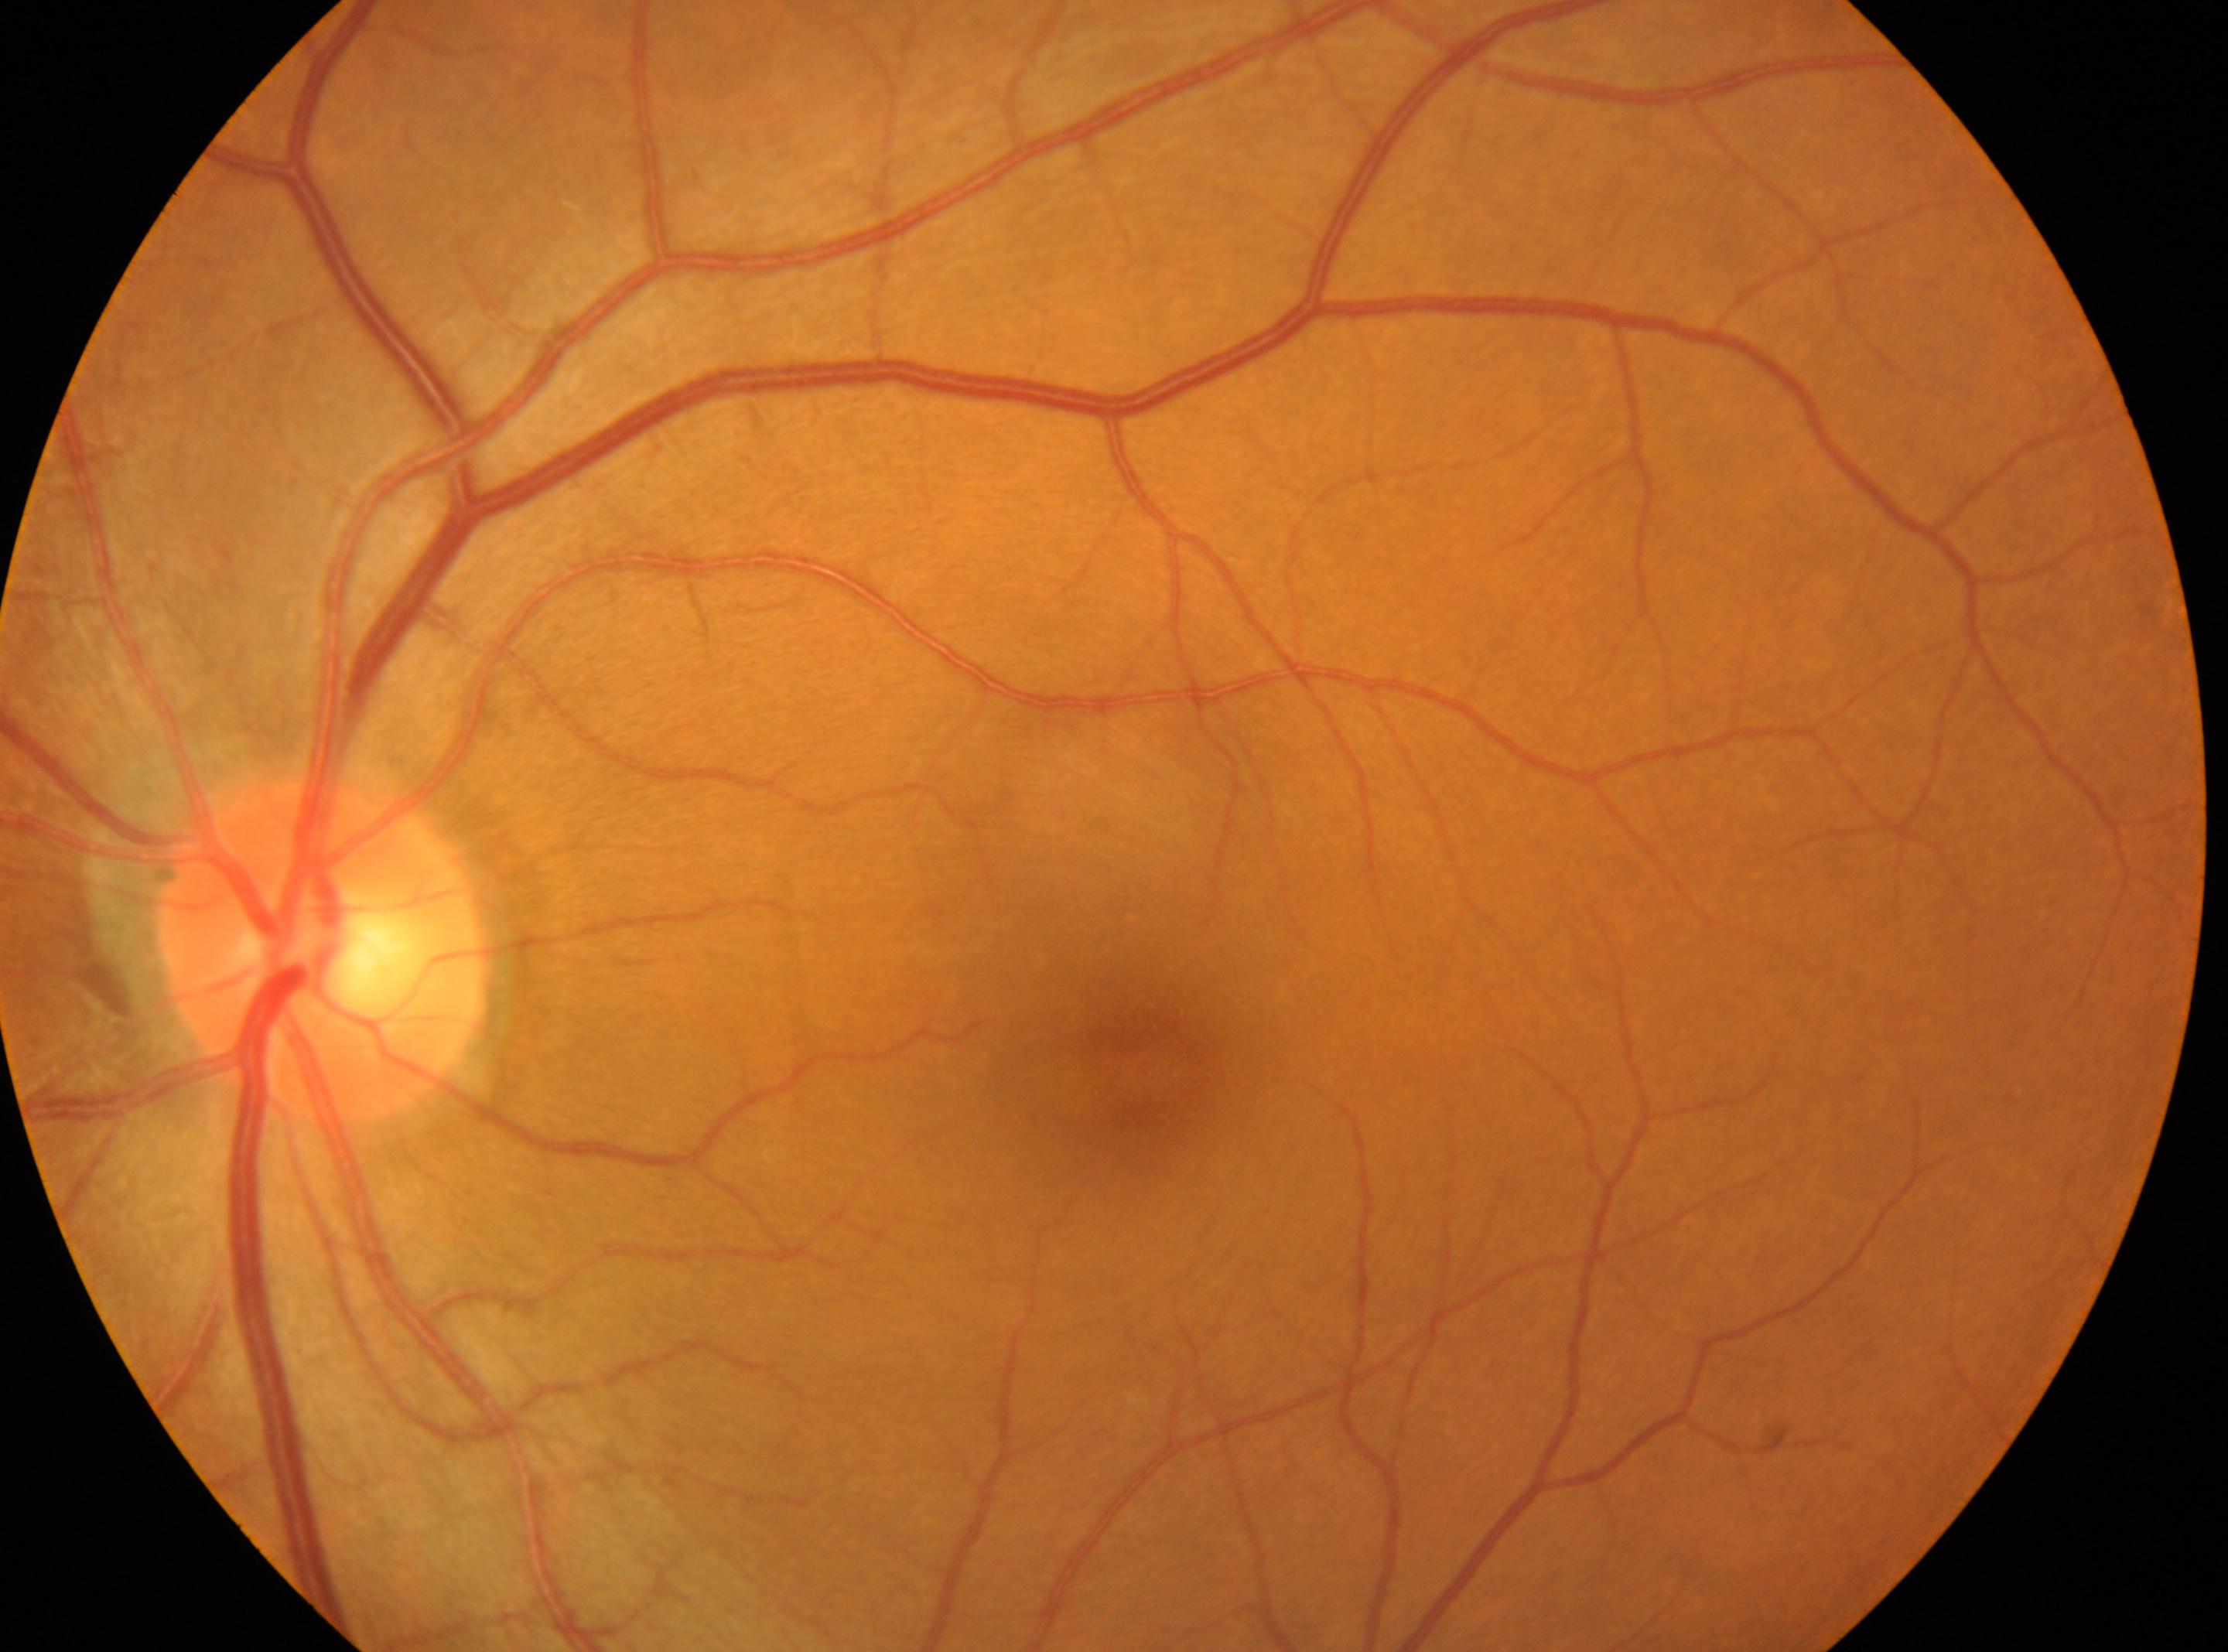 optic disc center = 320px, 951px
macular center = 1142px, 1064px
laterality = left eye
diabetic retinopathy (DR) = grade 0 (no apparent retinopathy)